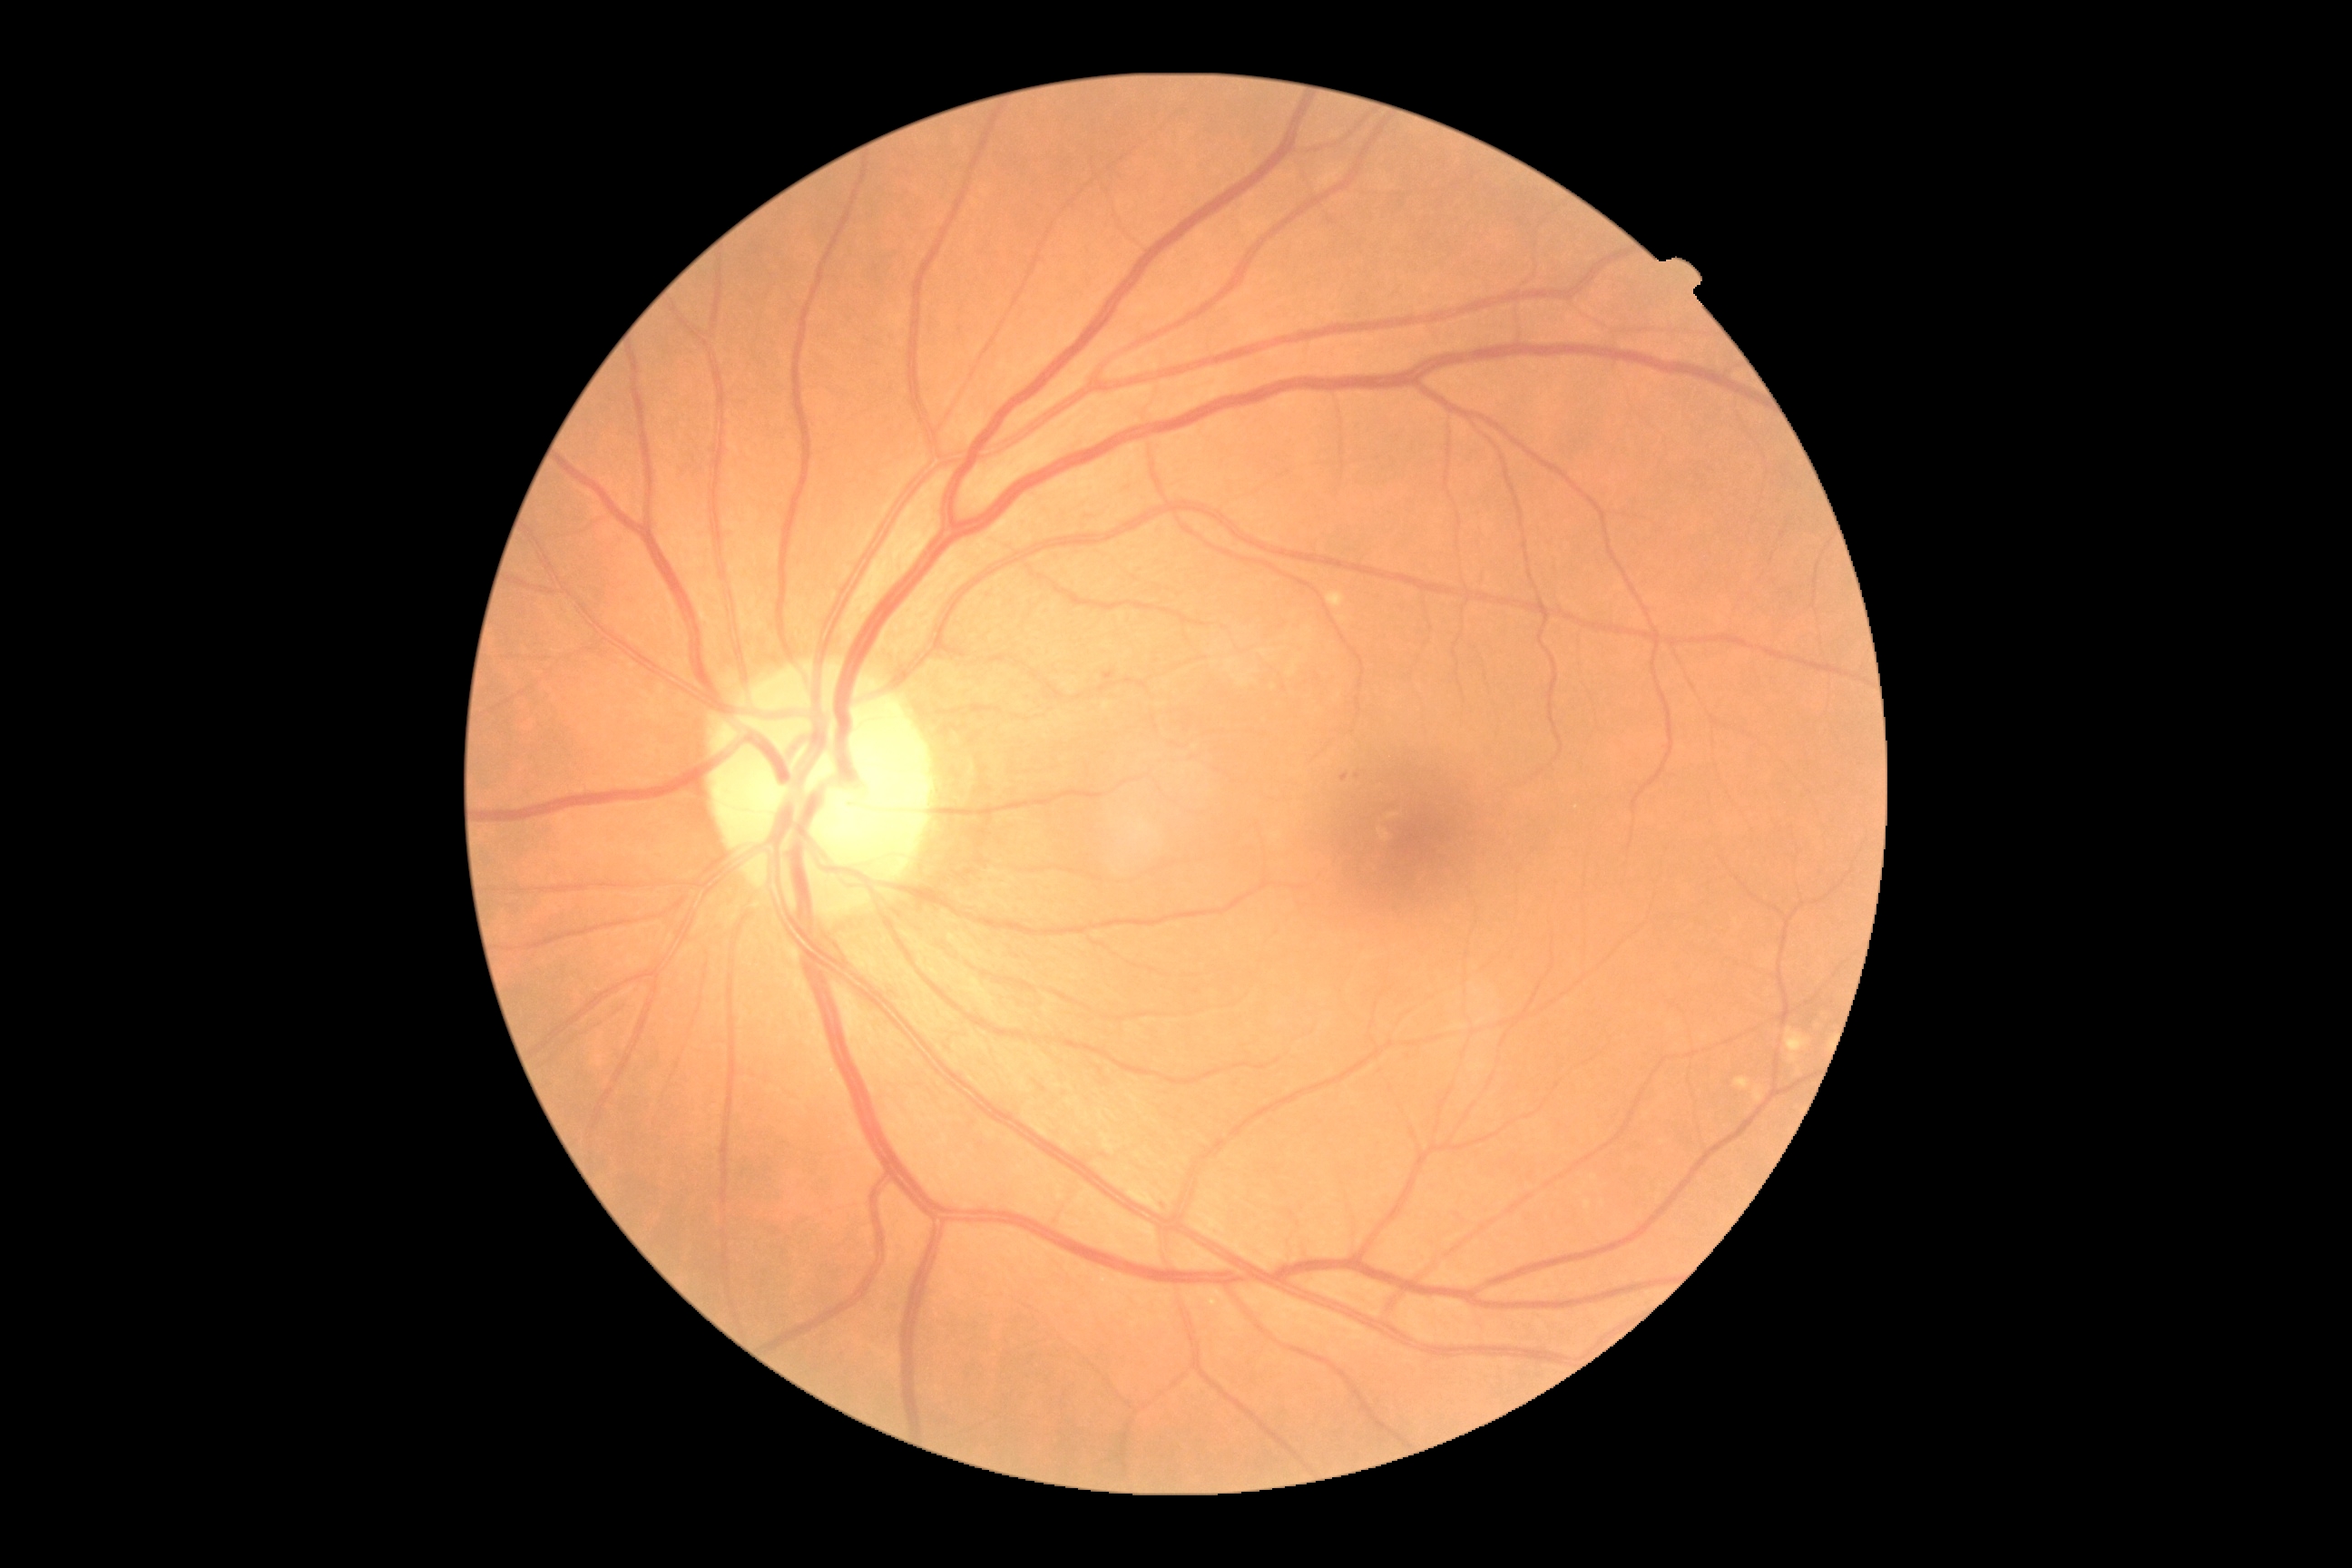
DR class = non-proliferative diabetic retinopathy | diabetic retinopathy severity = moderate non-proliferative diabetic retinopathy (grade 2).